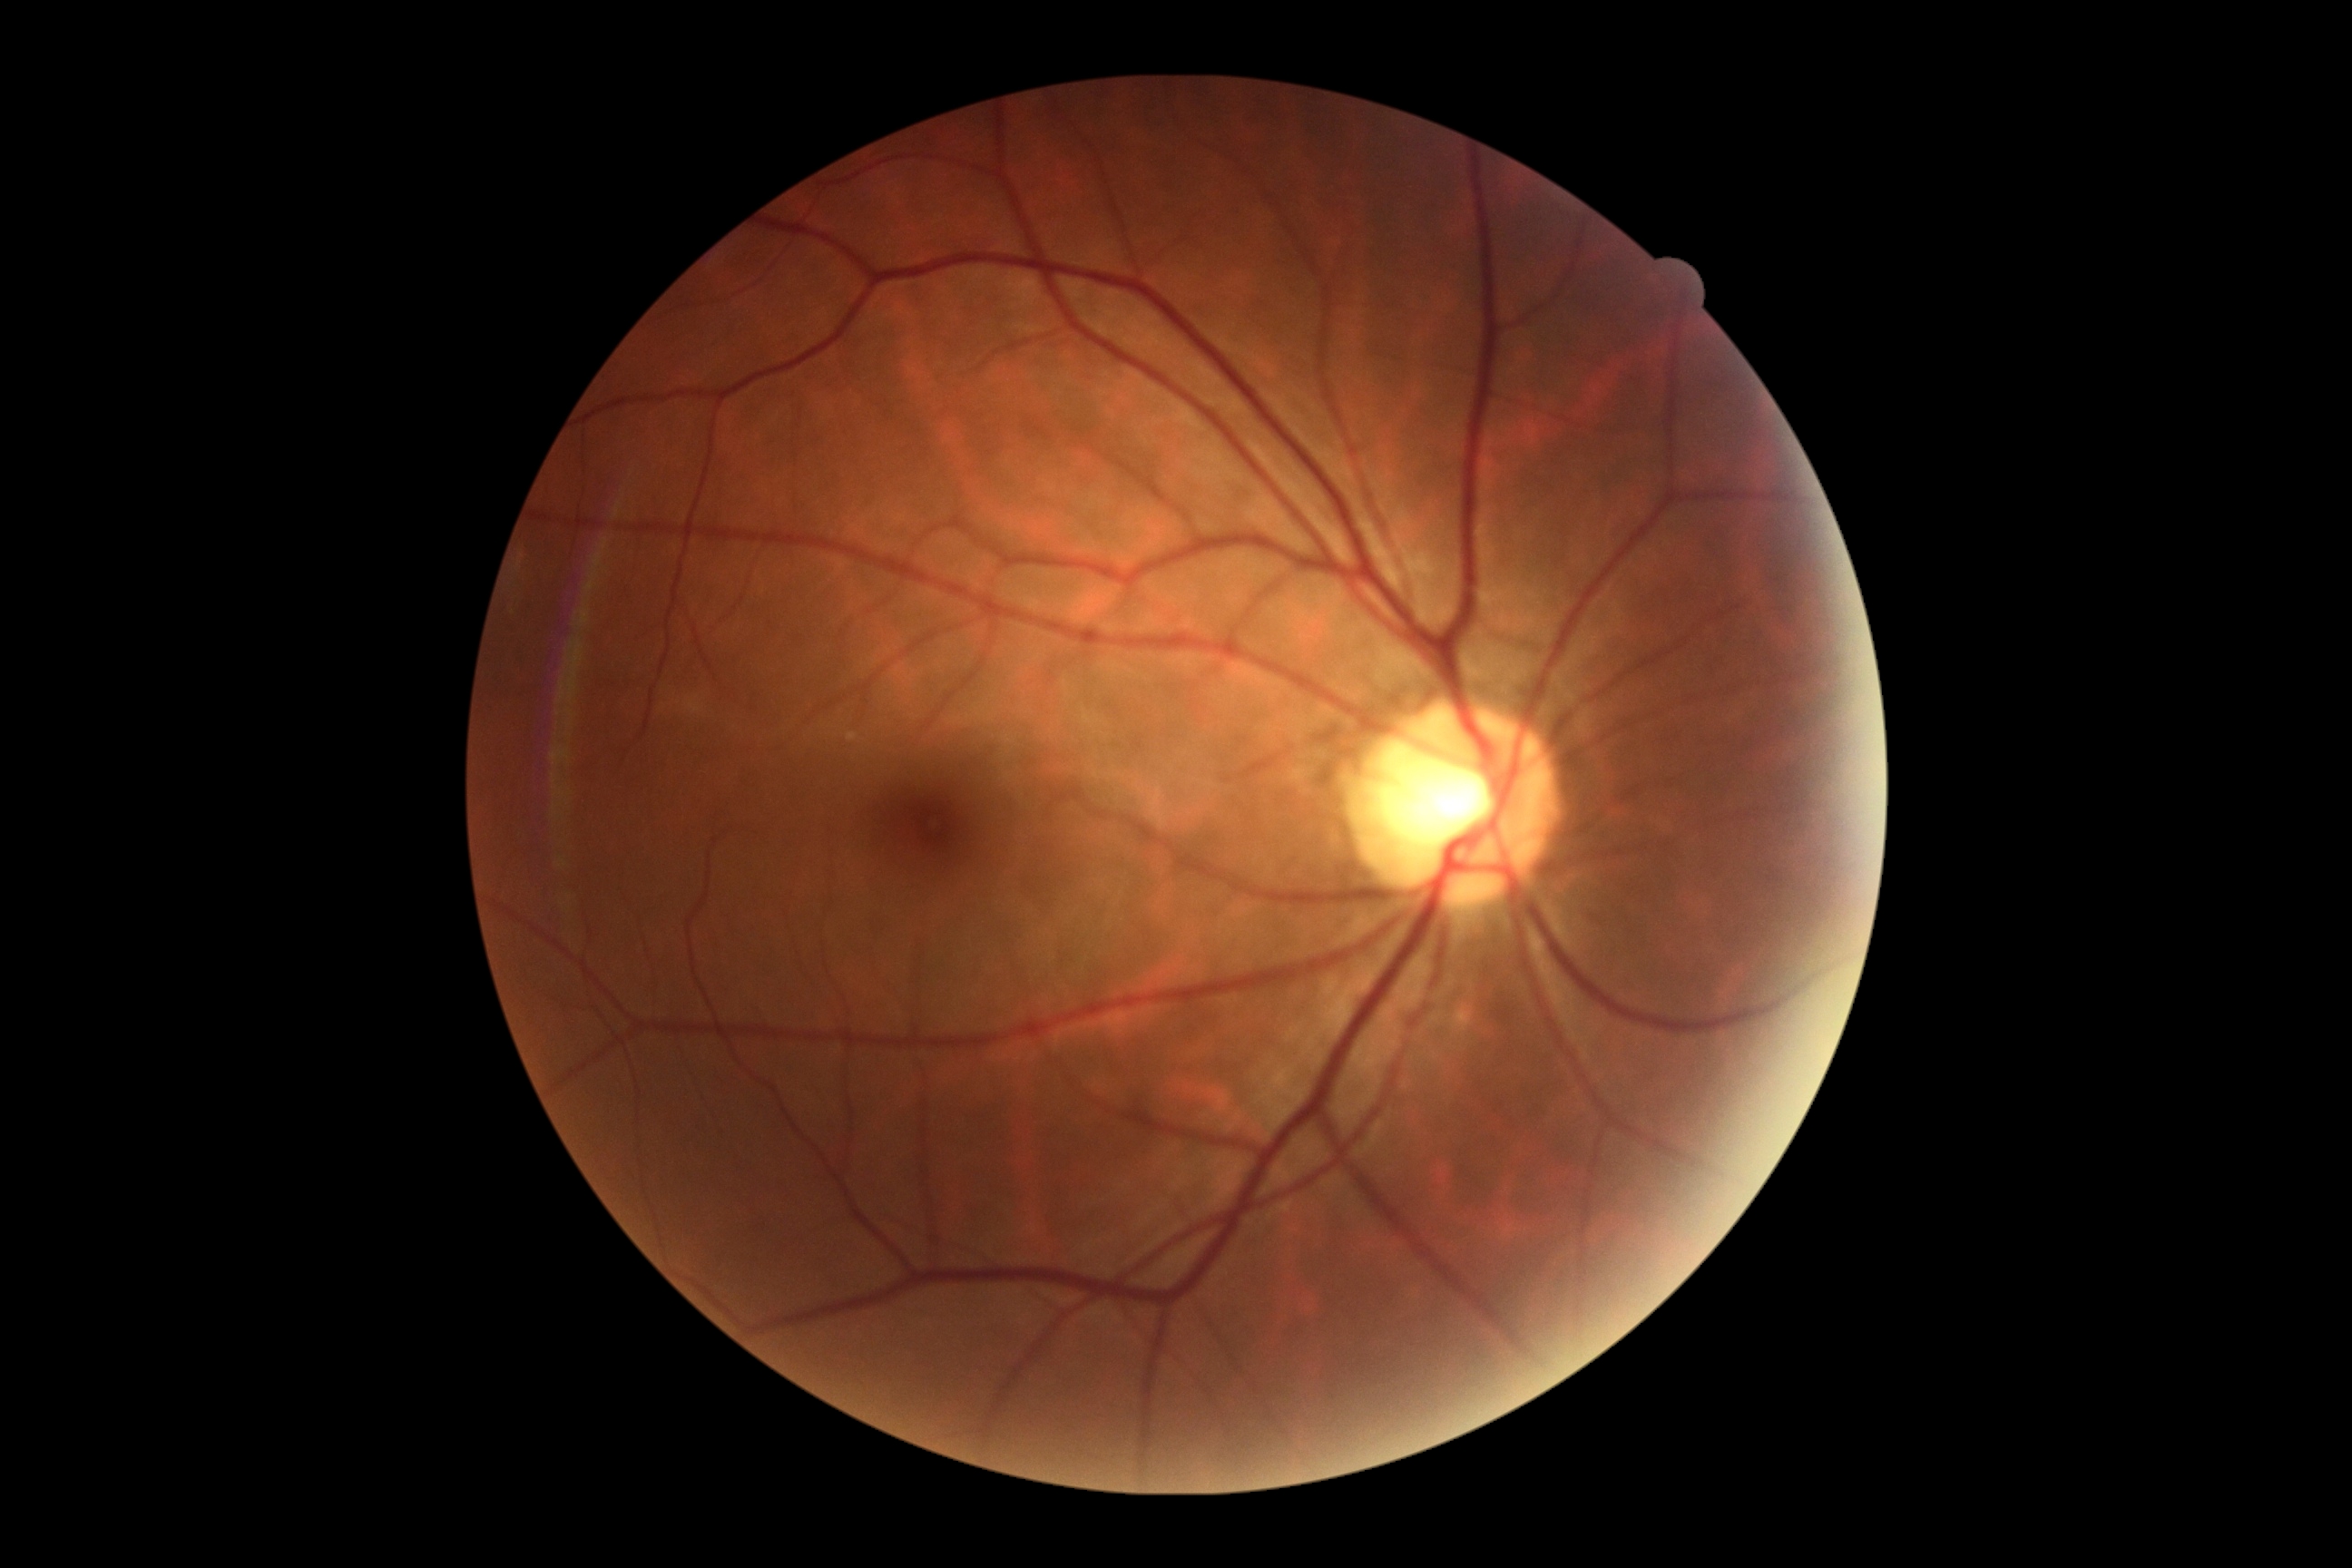

{
  "dr_impression": "no signs of DR",
  "dr_grade": "grade 0 (no apparent retinopathy)"
}